Color fundus image; 1659 x 2212 pixels; camera: Remidio Fundus on Phone.
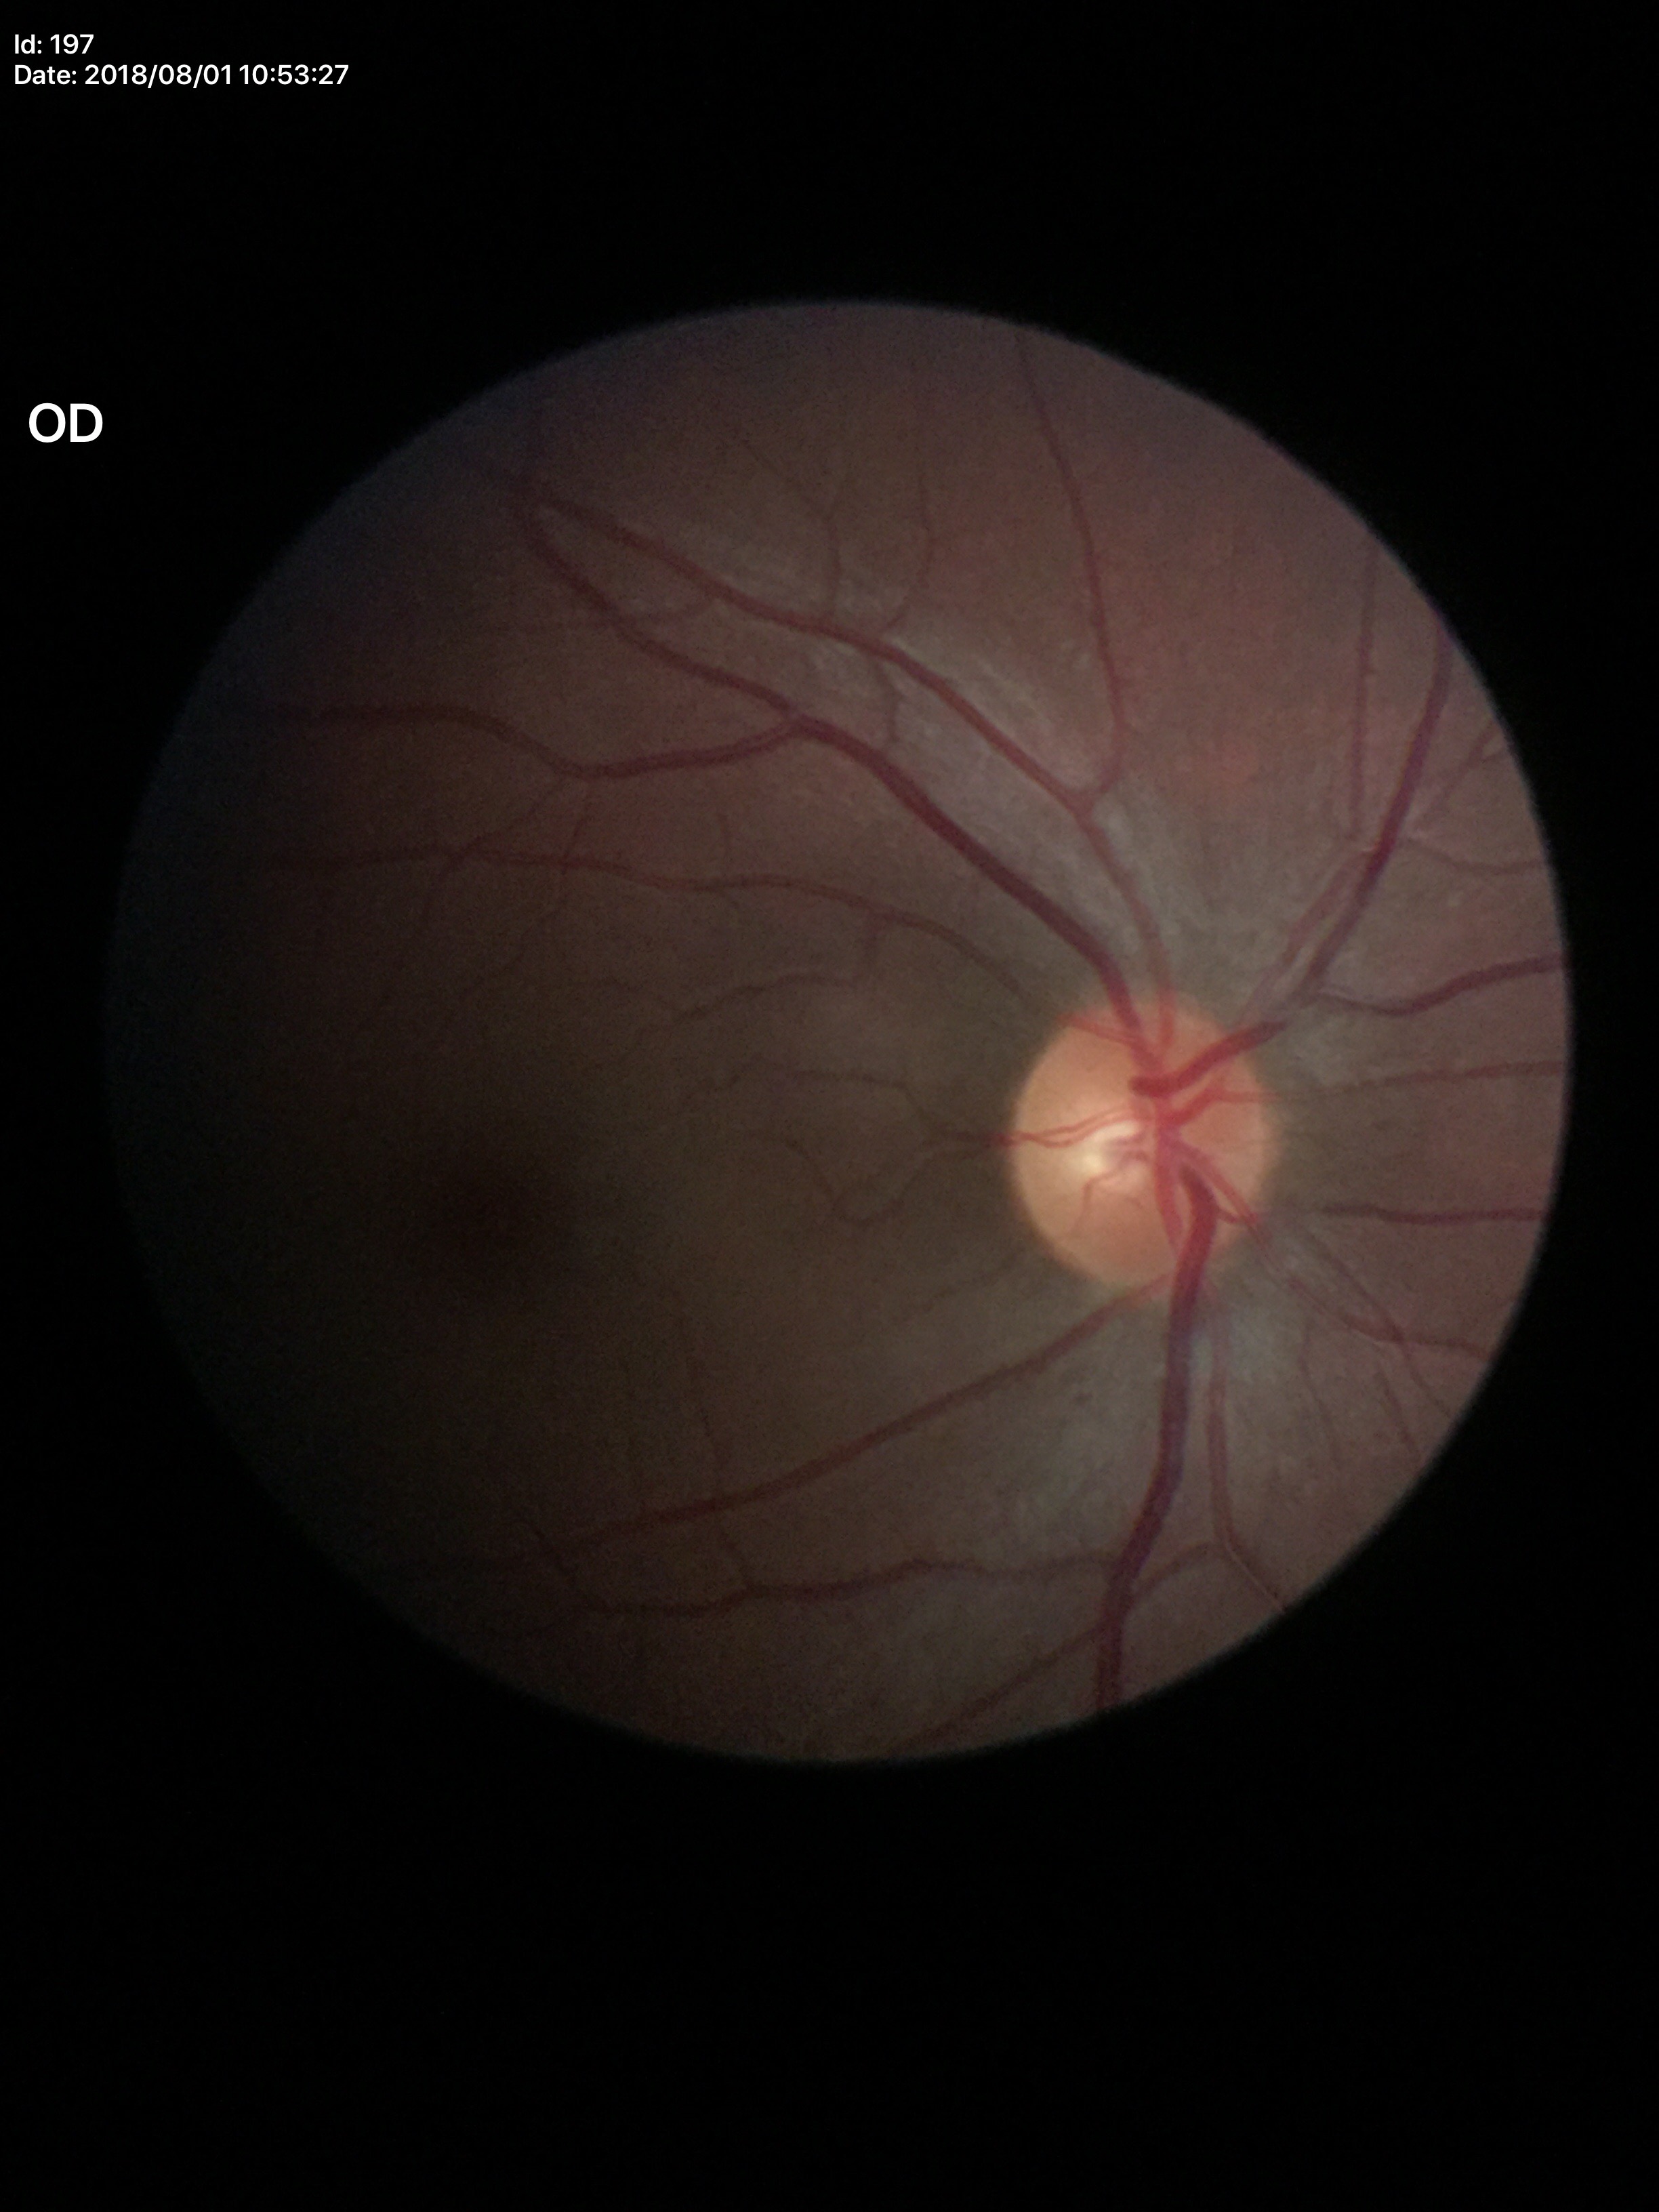

Glaucoma assessment: no suspicious findings (5/5 ophthalmologists in agreement). VCDR of 0.45.